512x512, fundus photo:
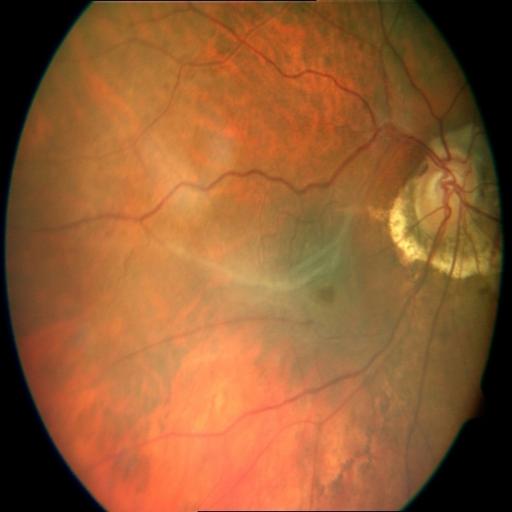

Findings (3): optic disc cupping; myopia; retinal traction.